Retinal fundus photograph: 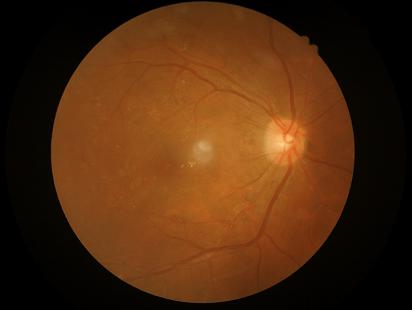 Overall image quality is good.
Contrast is good.
Image is sharp throughout the field.
Illumination is even.